45-degree field of view; fundus photo: 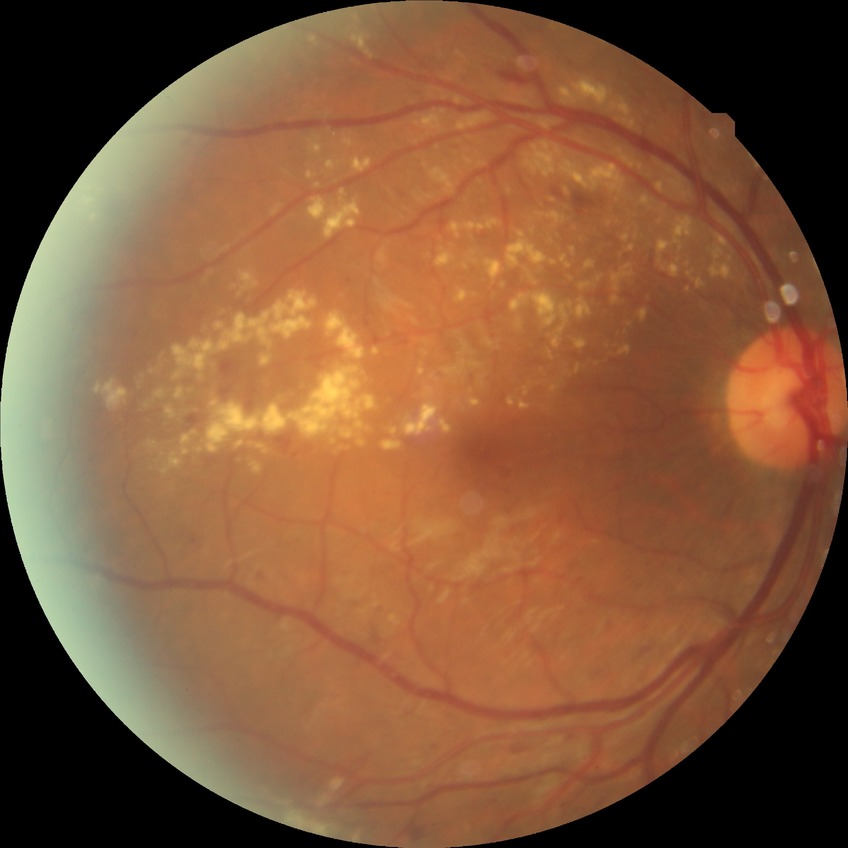
DR stage: PPDR. The retinopathy is classified as non-proliferative diabetic retinopathy.